Image size 1932x1916: 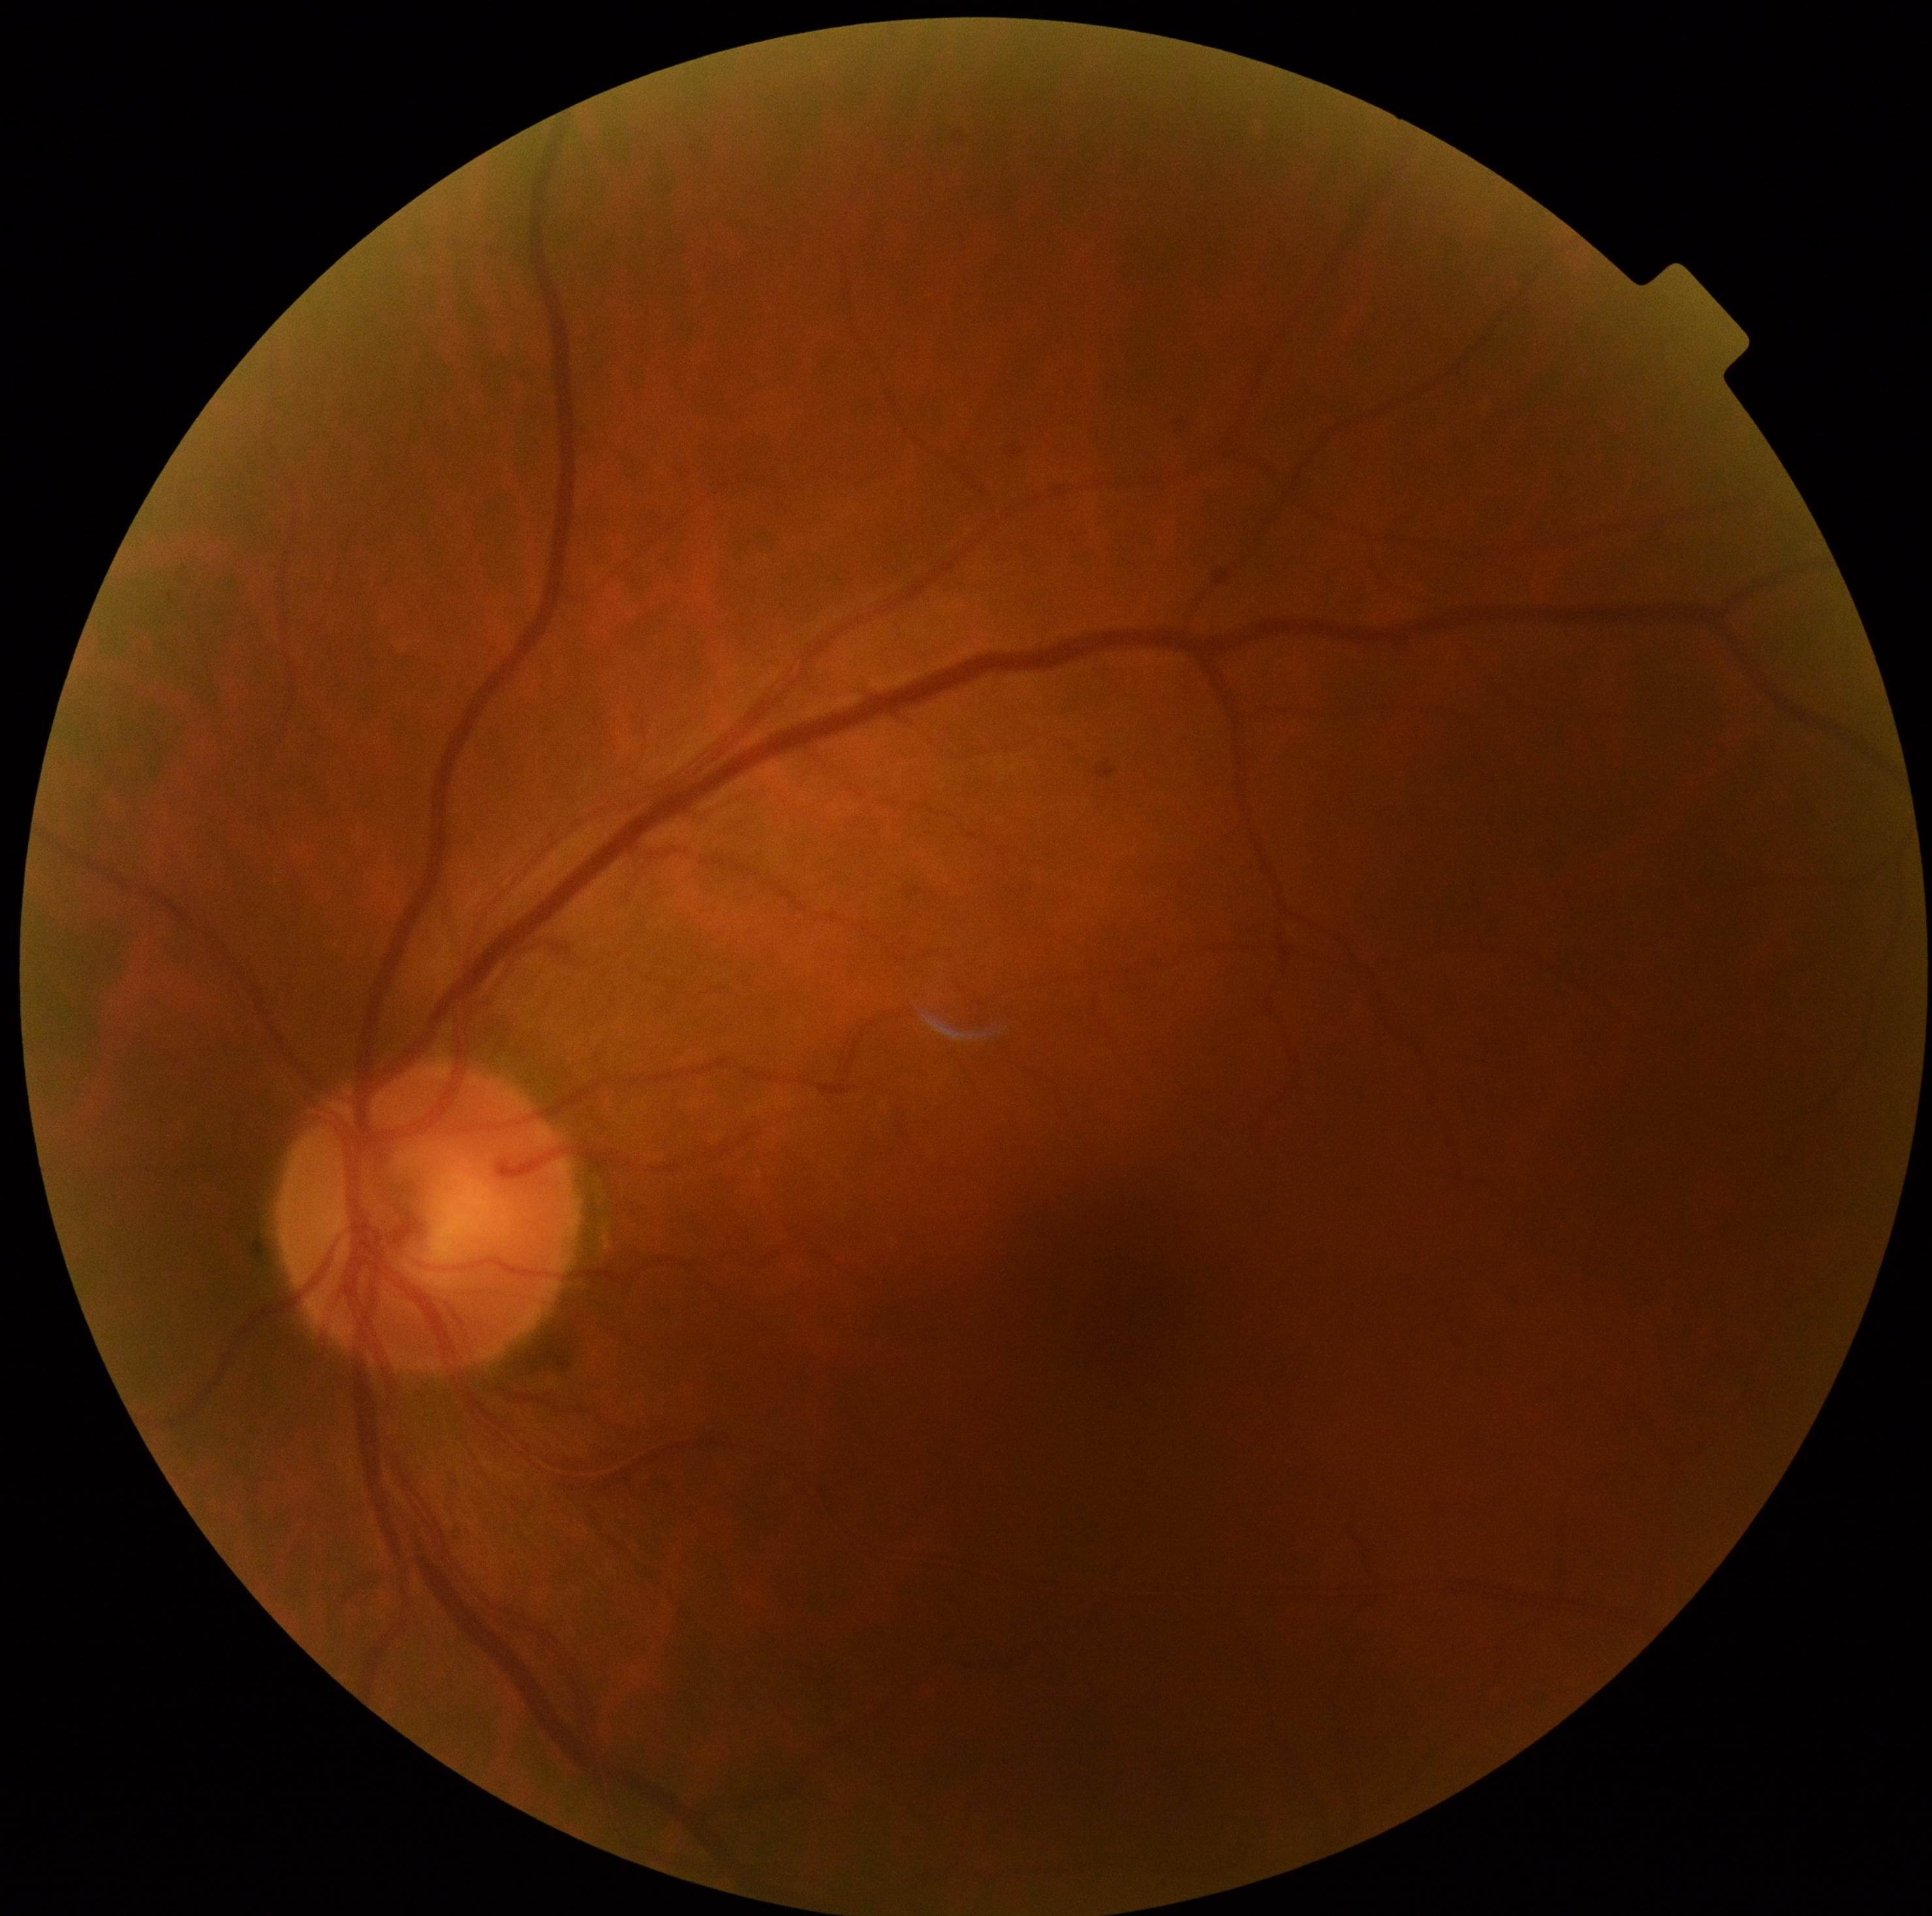 DR impression: no apparent DR, DR grade: 0.